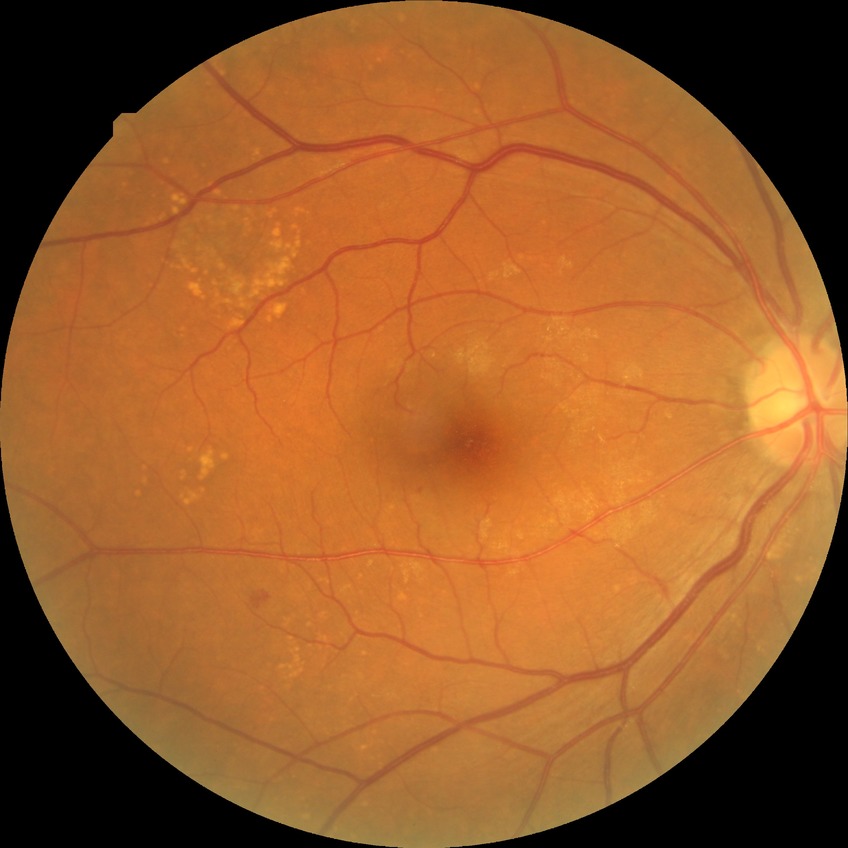

modified Davis classification=simple diabetic retinopathy.